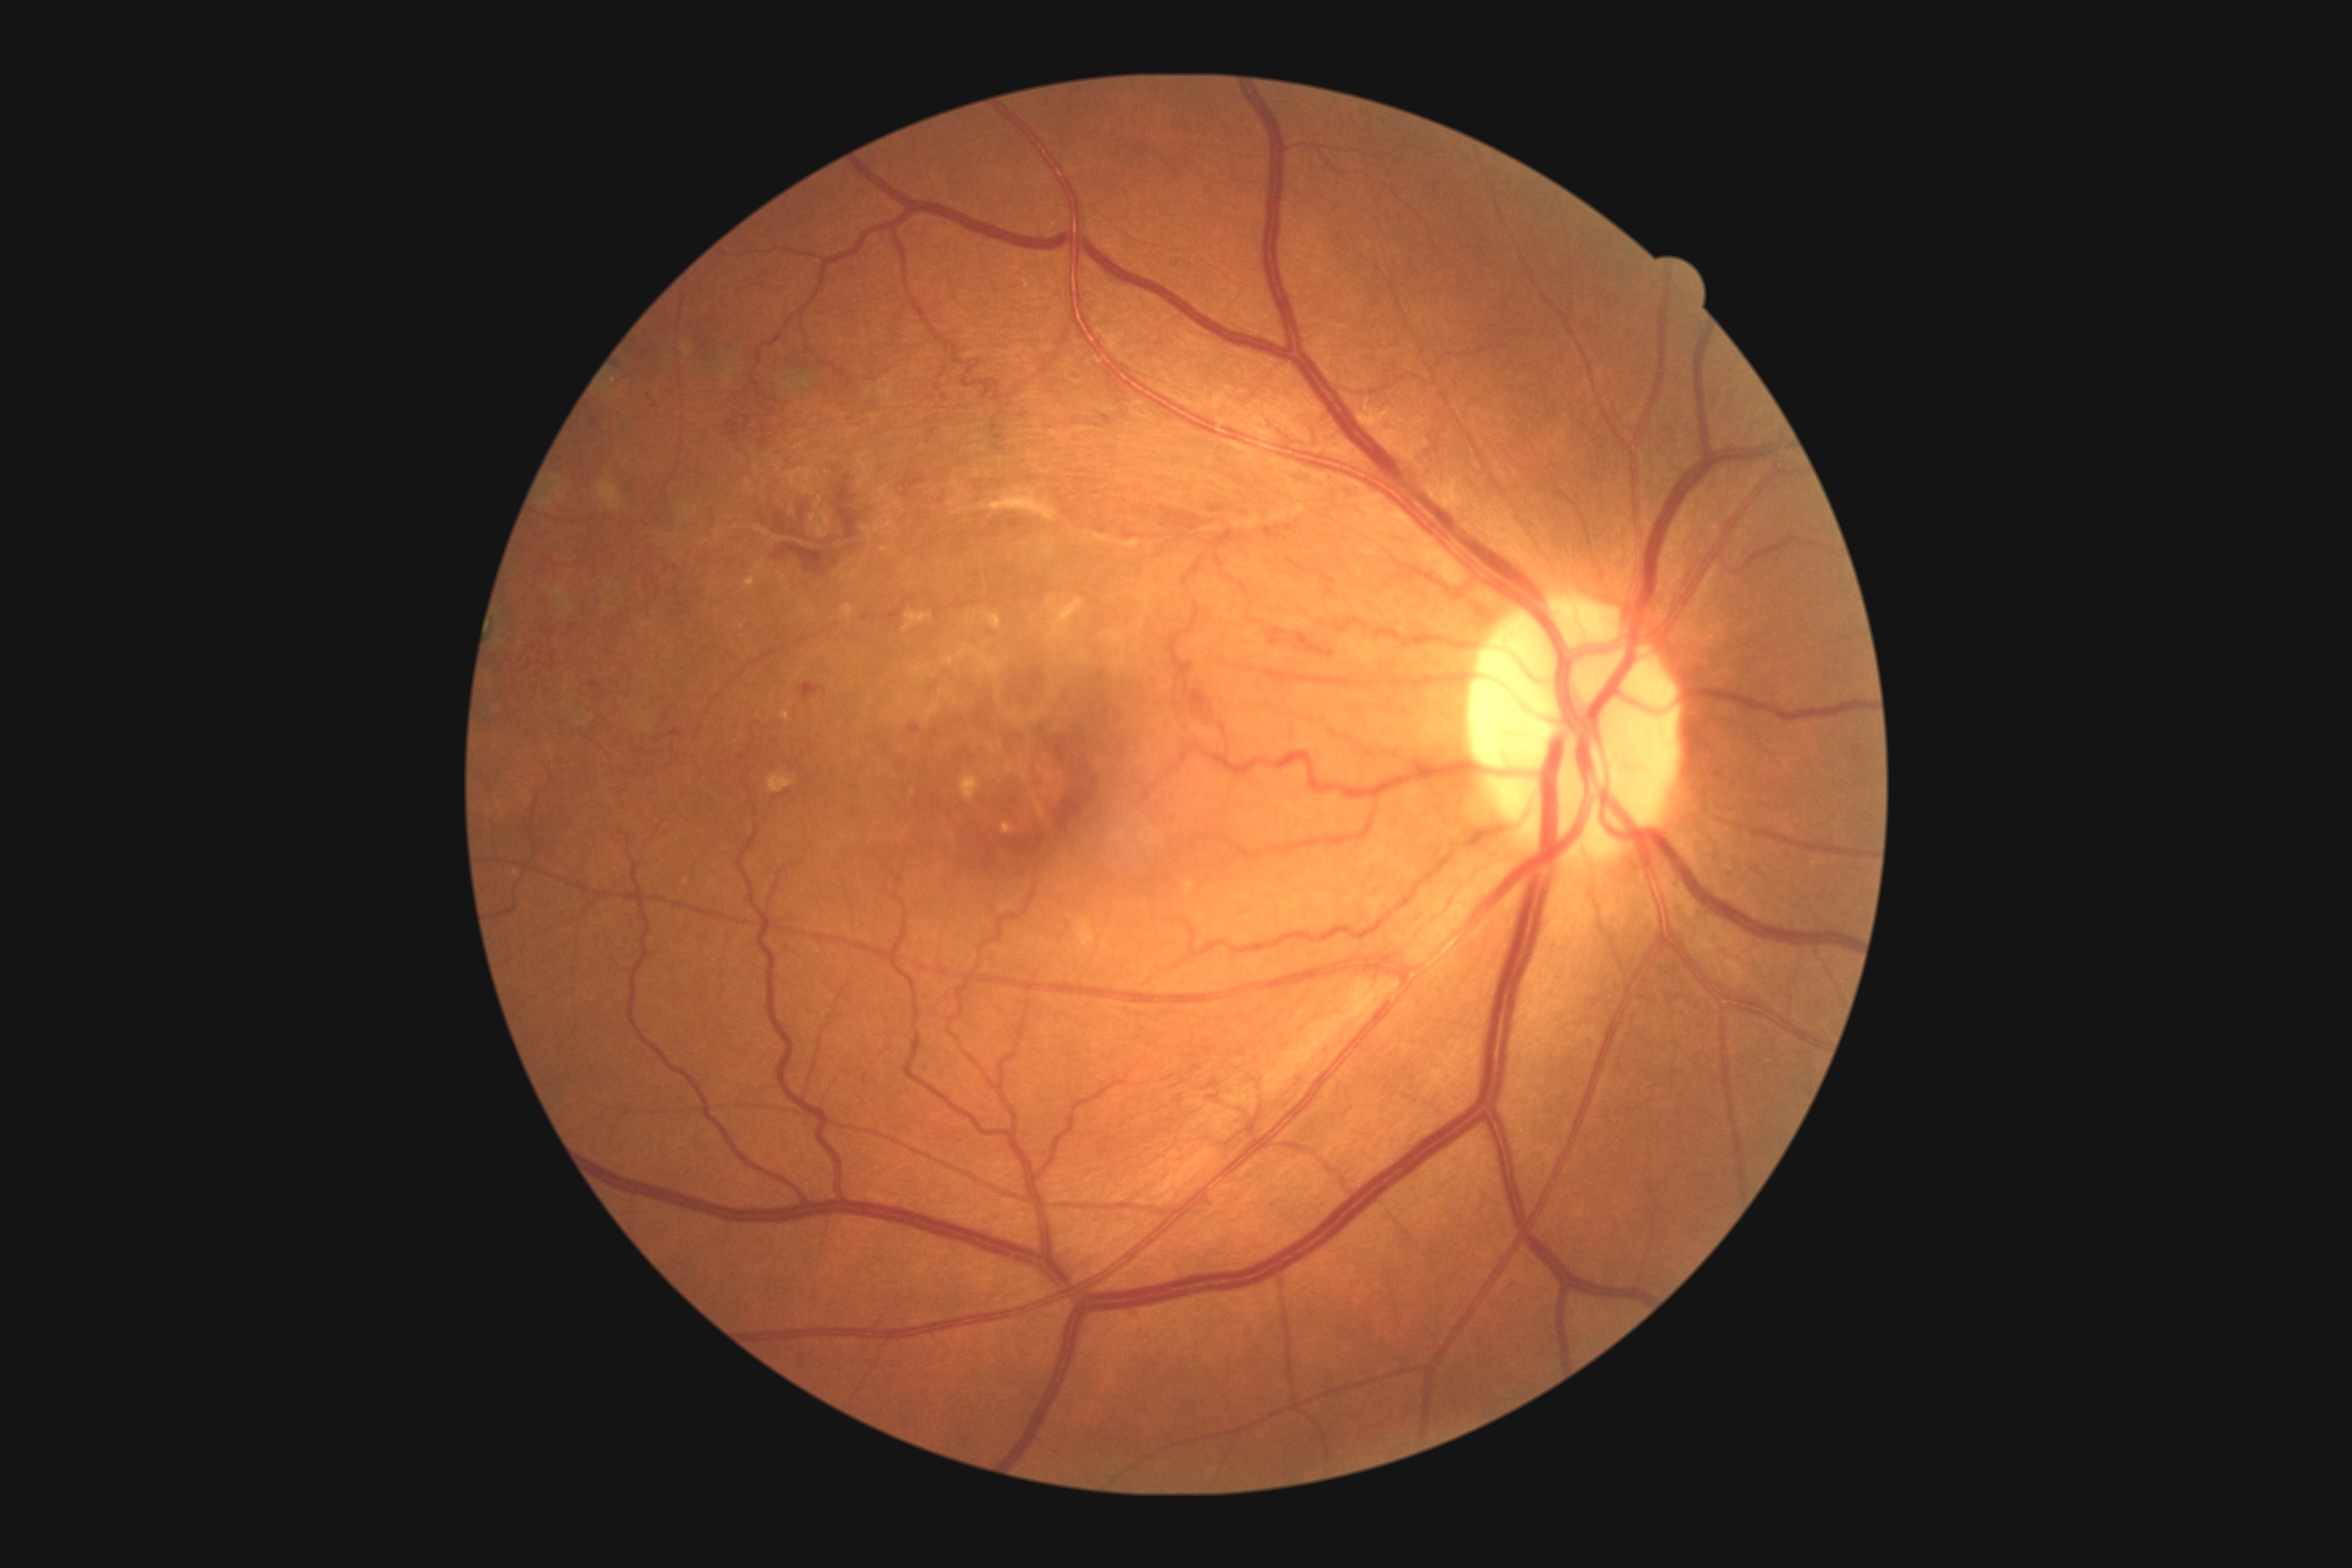 Diabetic retinopathy (DR): 3/4
Selected lesions:
• hemorrhages (HEs) (continued): [1068,371,1079,380] | [1295,632,1324,656] | [671,729,681,738] | [1157,507,1211,538] | [1326,651,1335,658] | [721,380,790,466] | [974,482,983,489] | [799,683,827,703] | [1210,505,1224,514] | [1340,484,1362,500] | [930,683,939,692]
• Smaller HEs around [945,398] | [942,502] | [650,397] | [931,397]